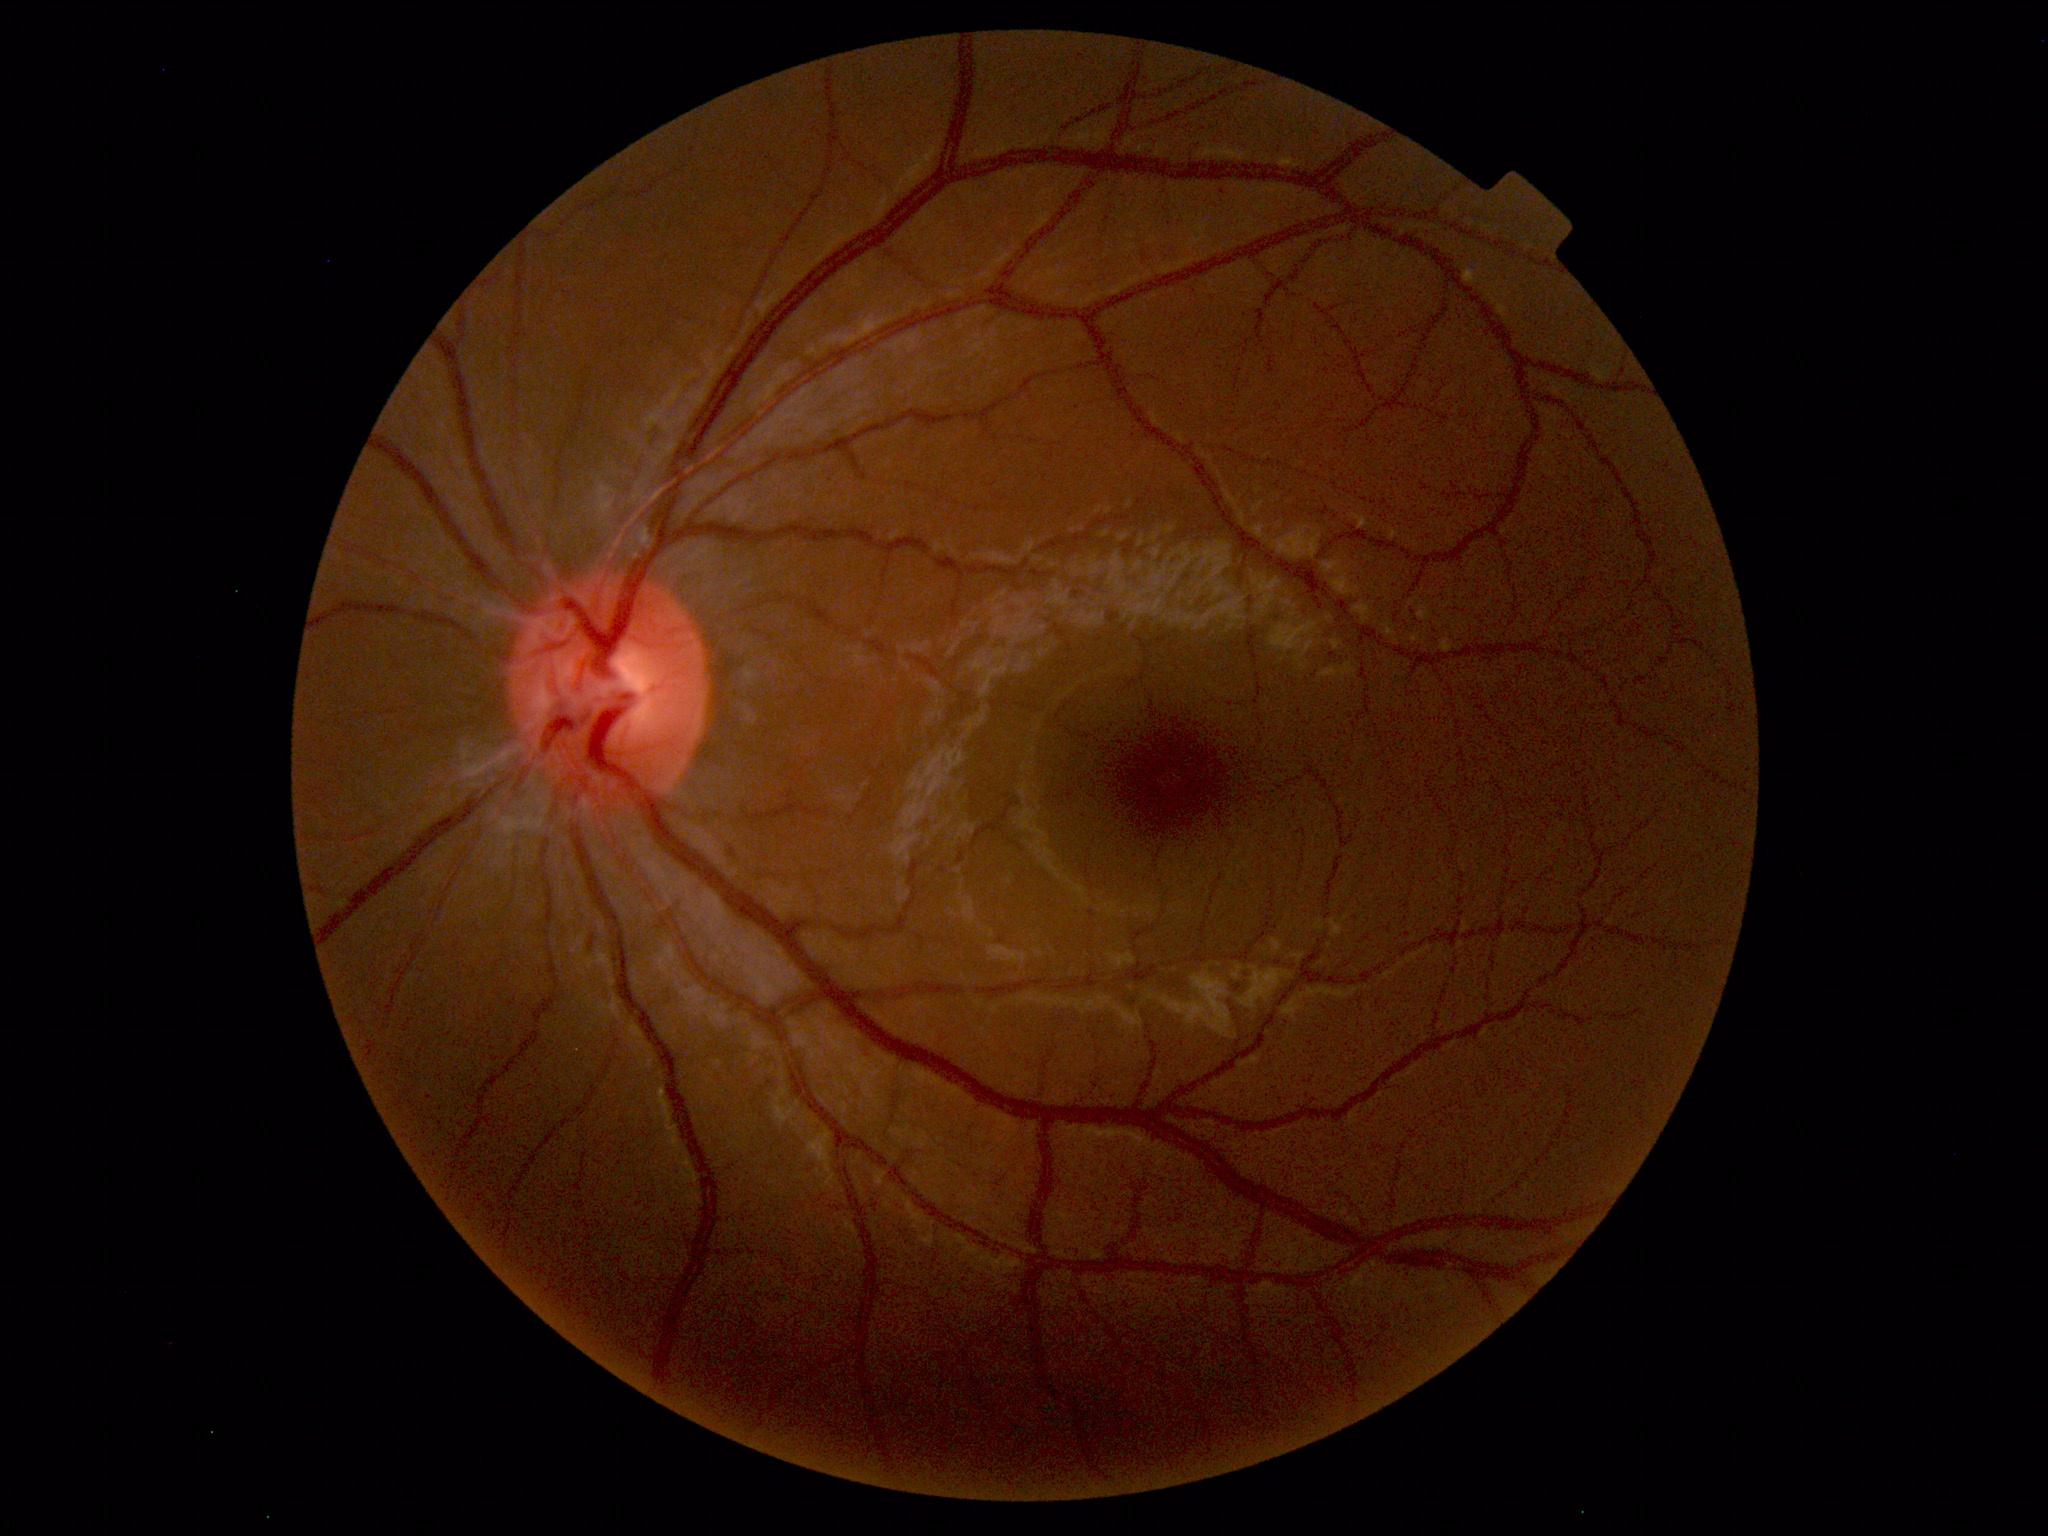
Findings: none. Normal fundus.